Wide-field fundus photograph of an infant.
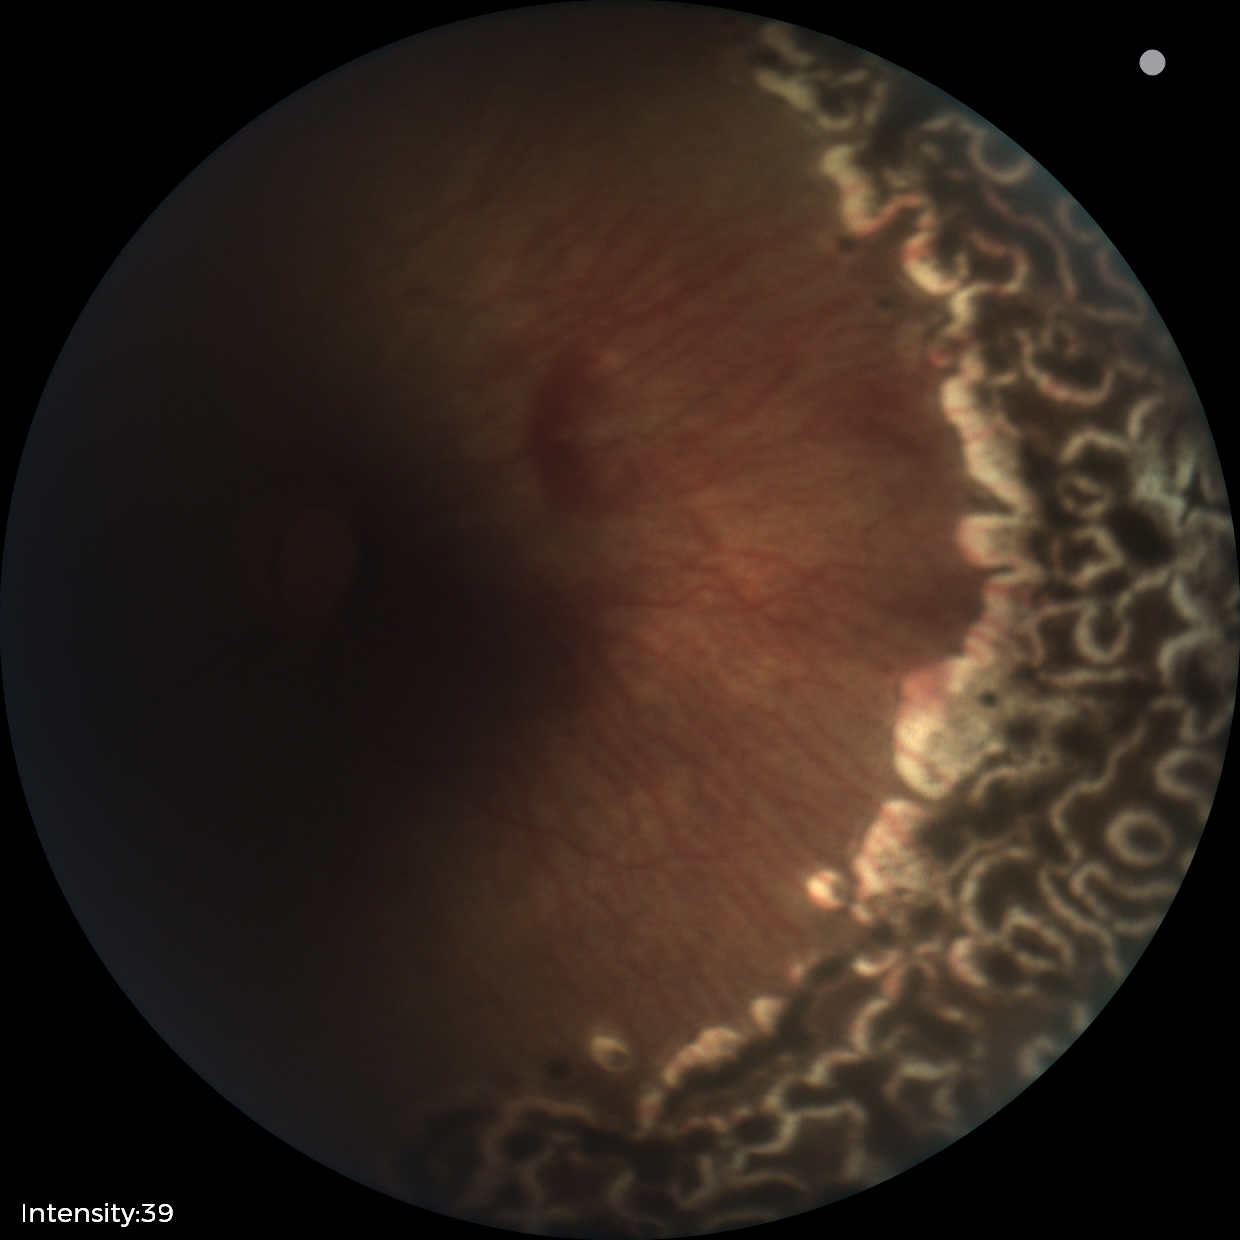
Plus disease absent.
Screening series with status post retinopathy of prematurity.